Camera: NIDEK AFC-230, fundus photo:
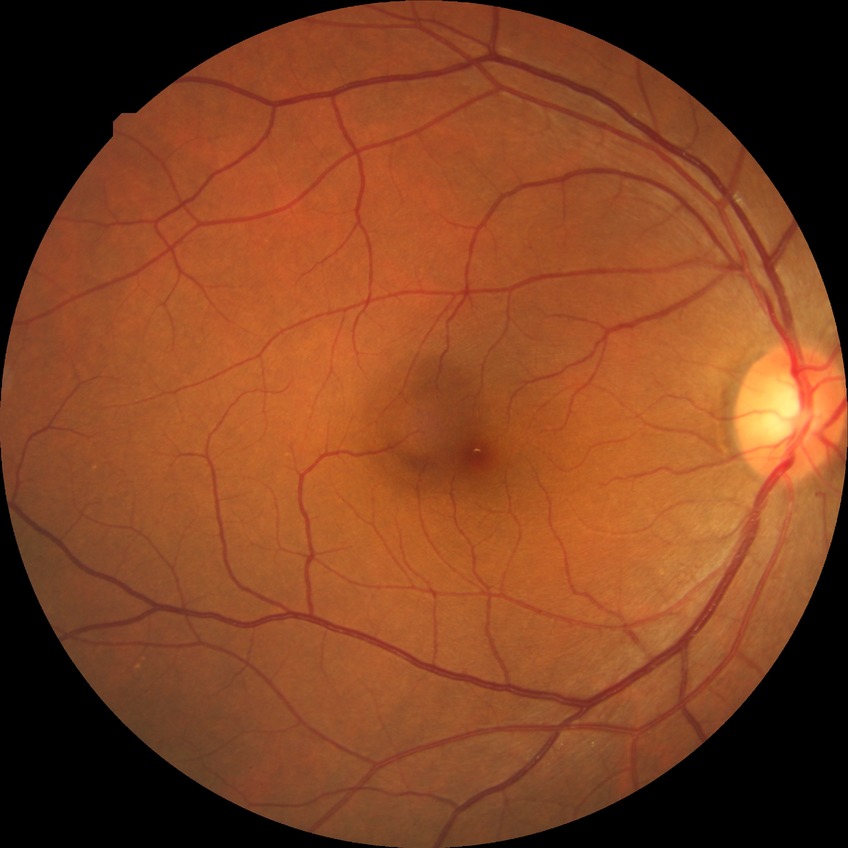

Retinopathy stage: no diabetic retinopathy.